Color fundus image.
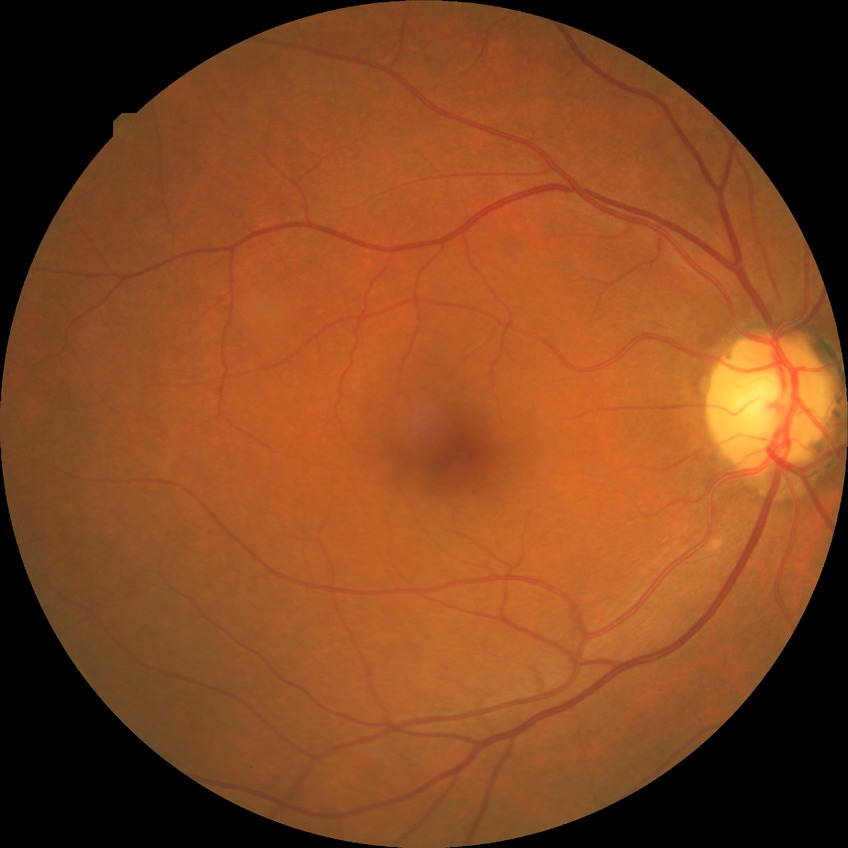 DR impression=no apparent DR; Davis stage=NDR.